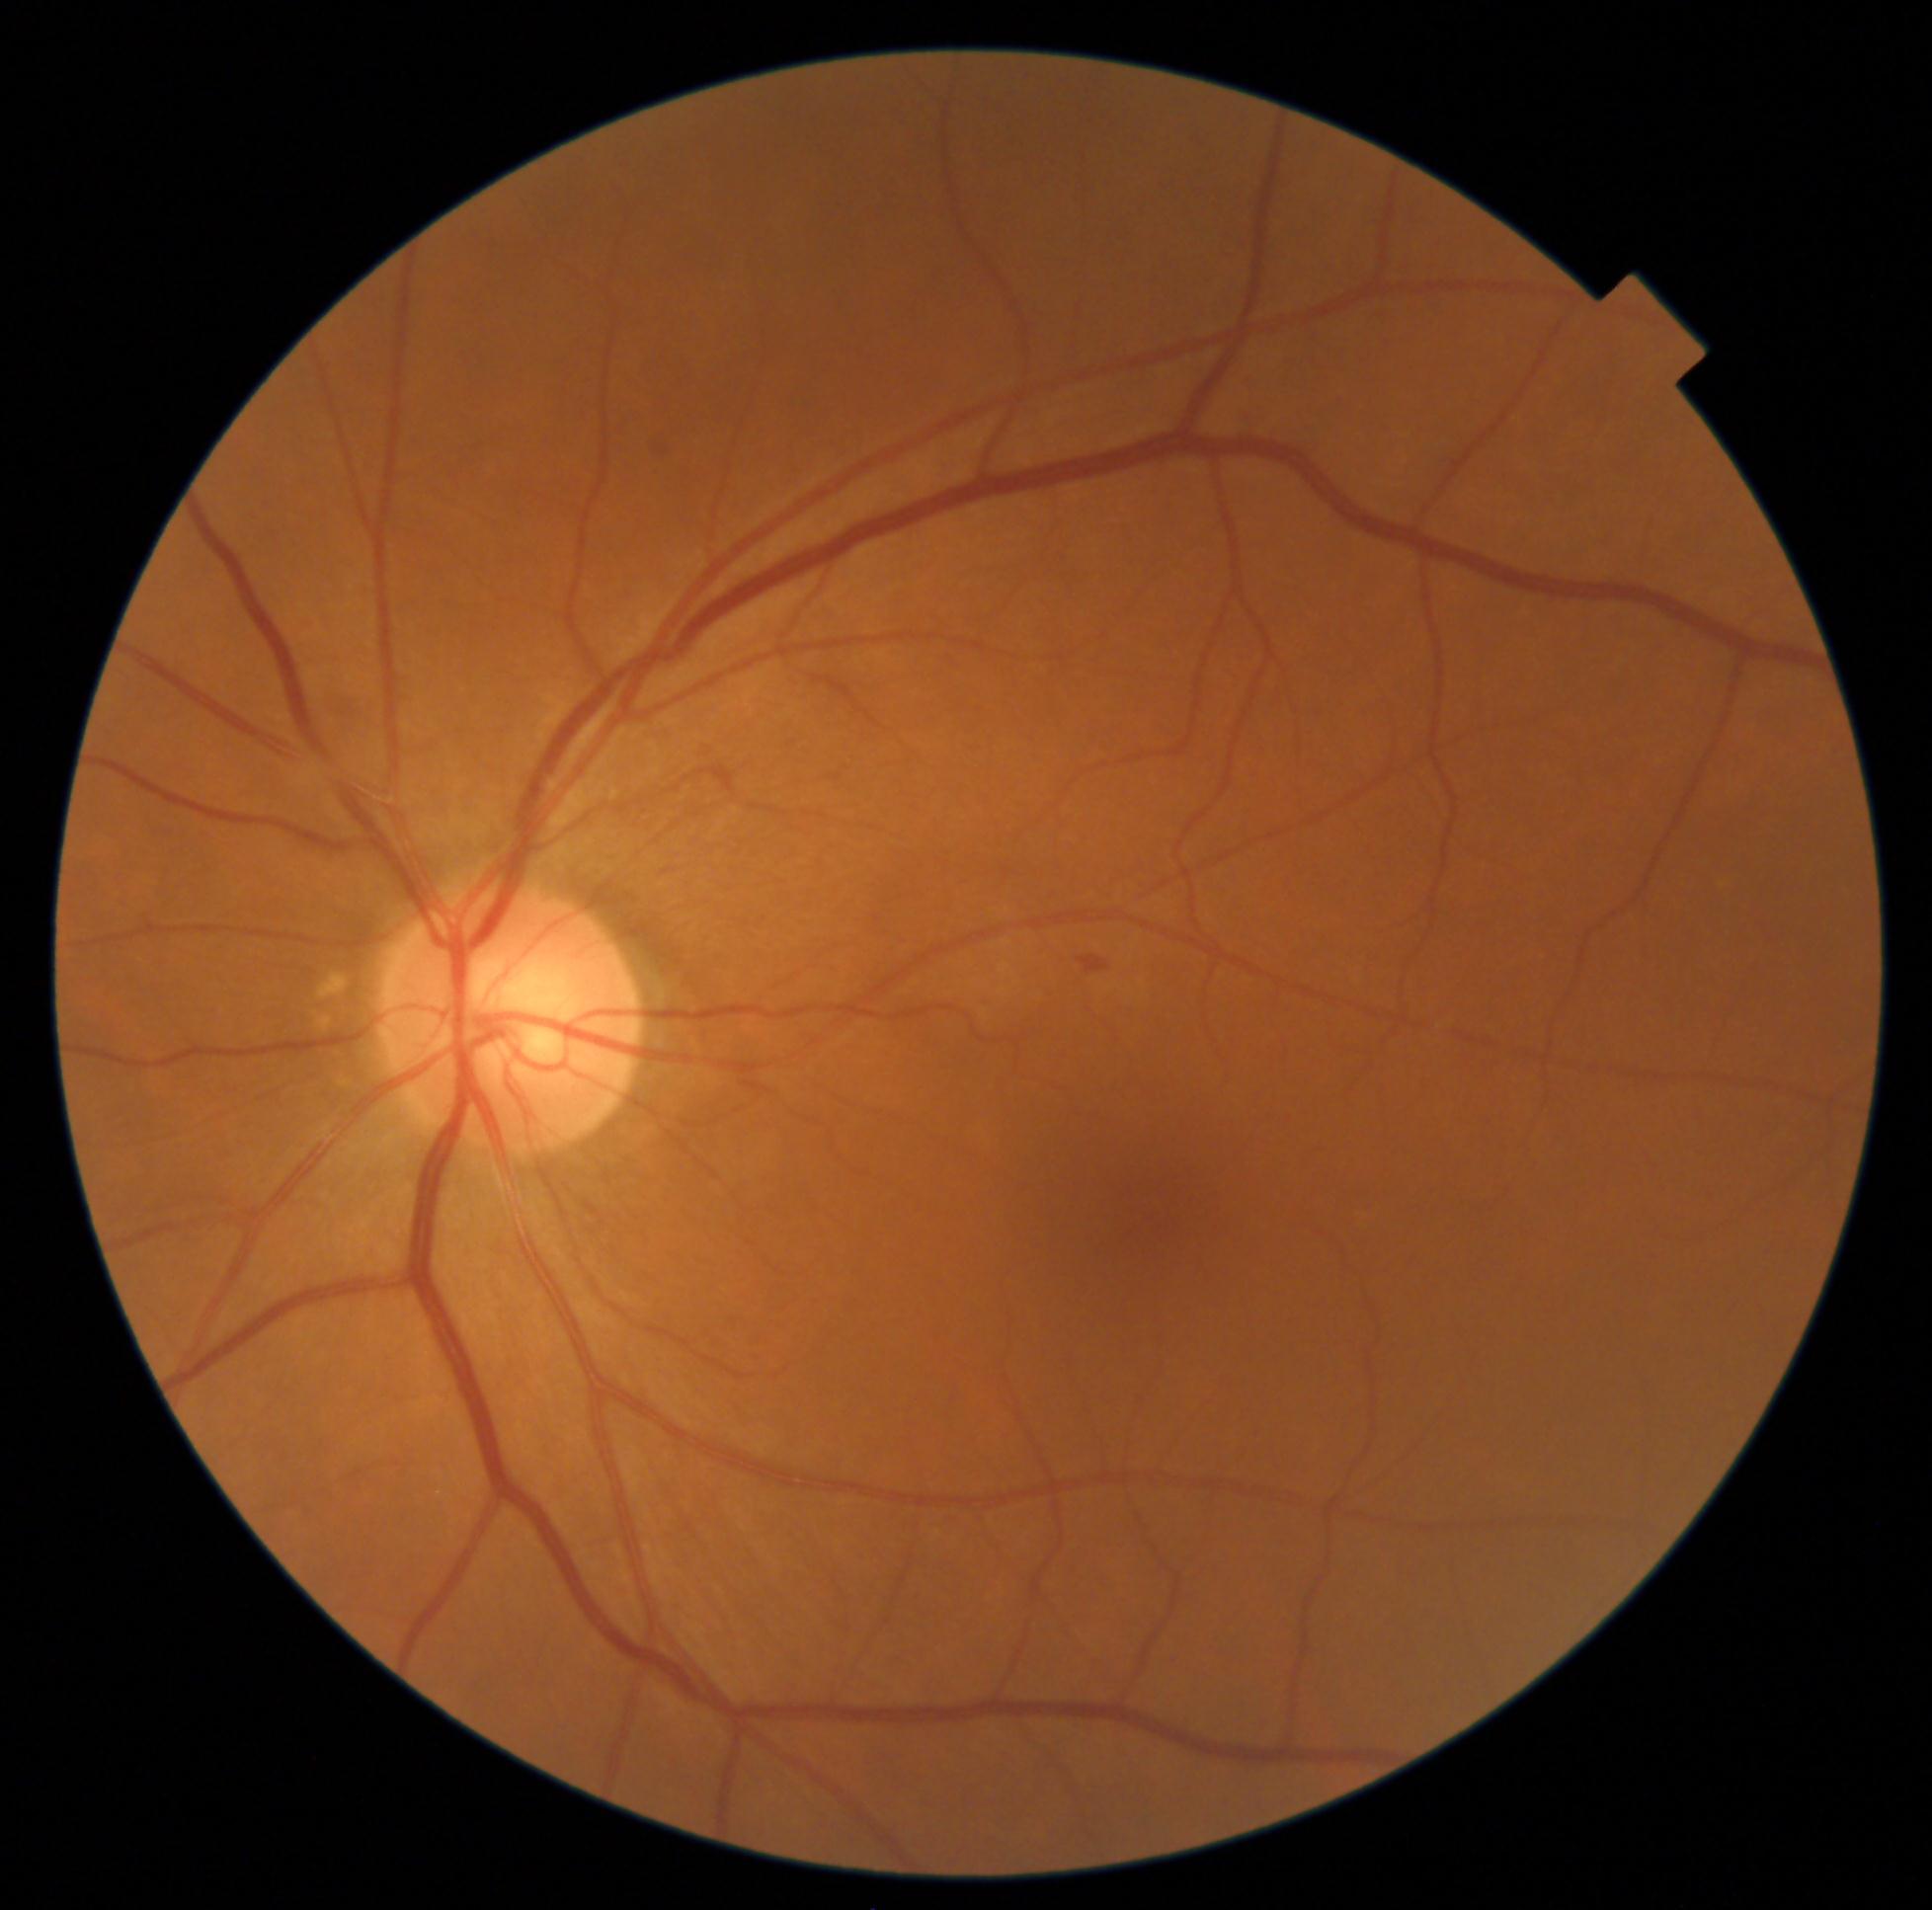 Diabetic retinopathy (DR): moderate non-proliferative diabetic retinopathy (grade 2) — more than just microaneurysms but less than severe NPDR.